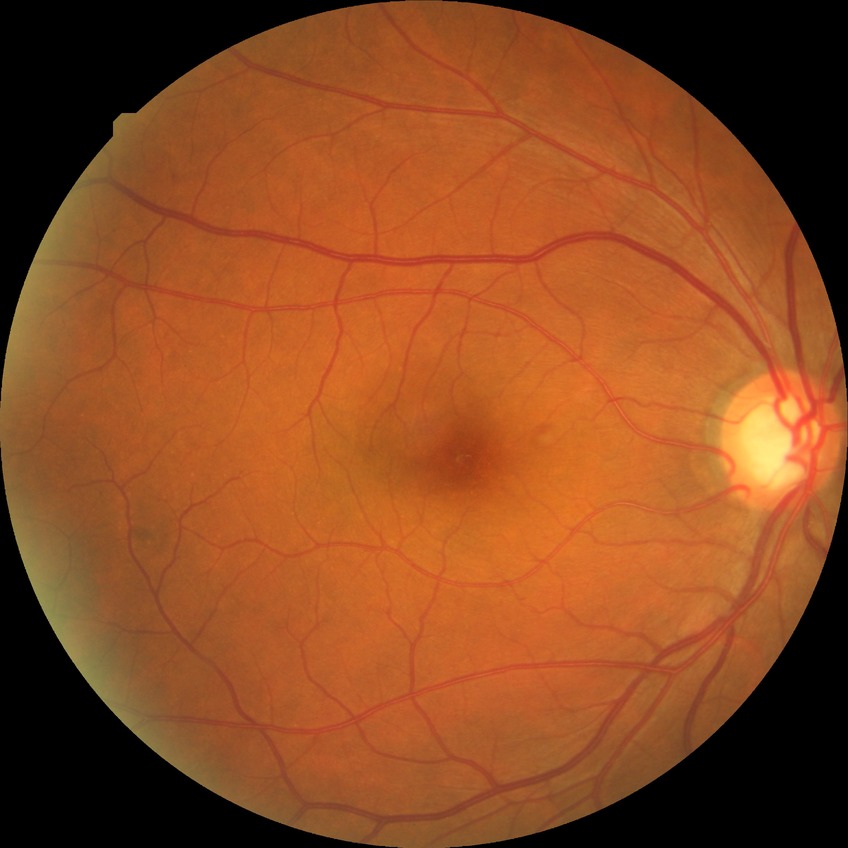 Diabetic retinopathy (DR): NDR (no diabetic retinopathy).